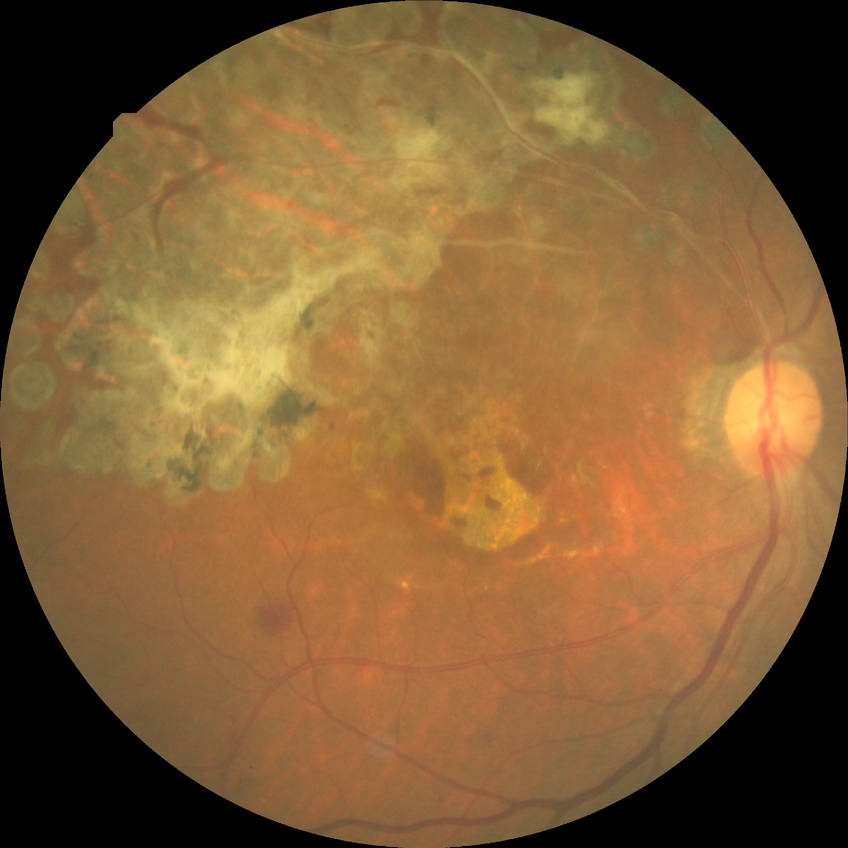
DR class=non-proliferative diabetic retinopathy, modified Davis classification=simple diabetic retinopathy.